1932 by 1932 pixels
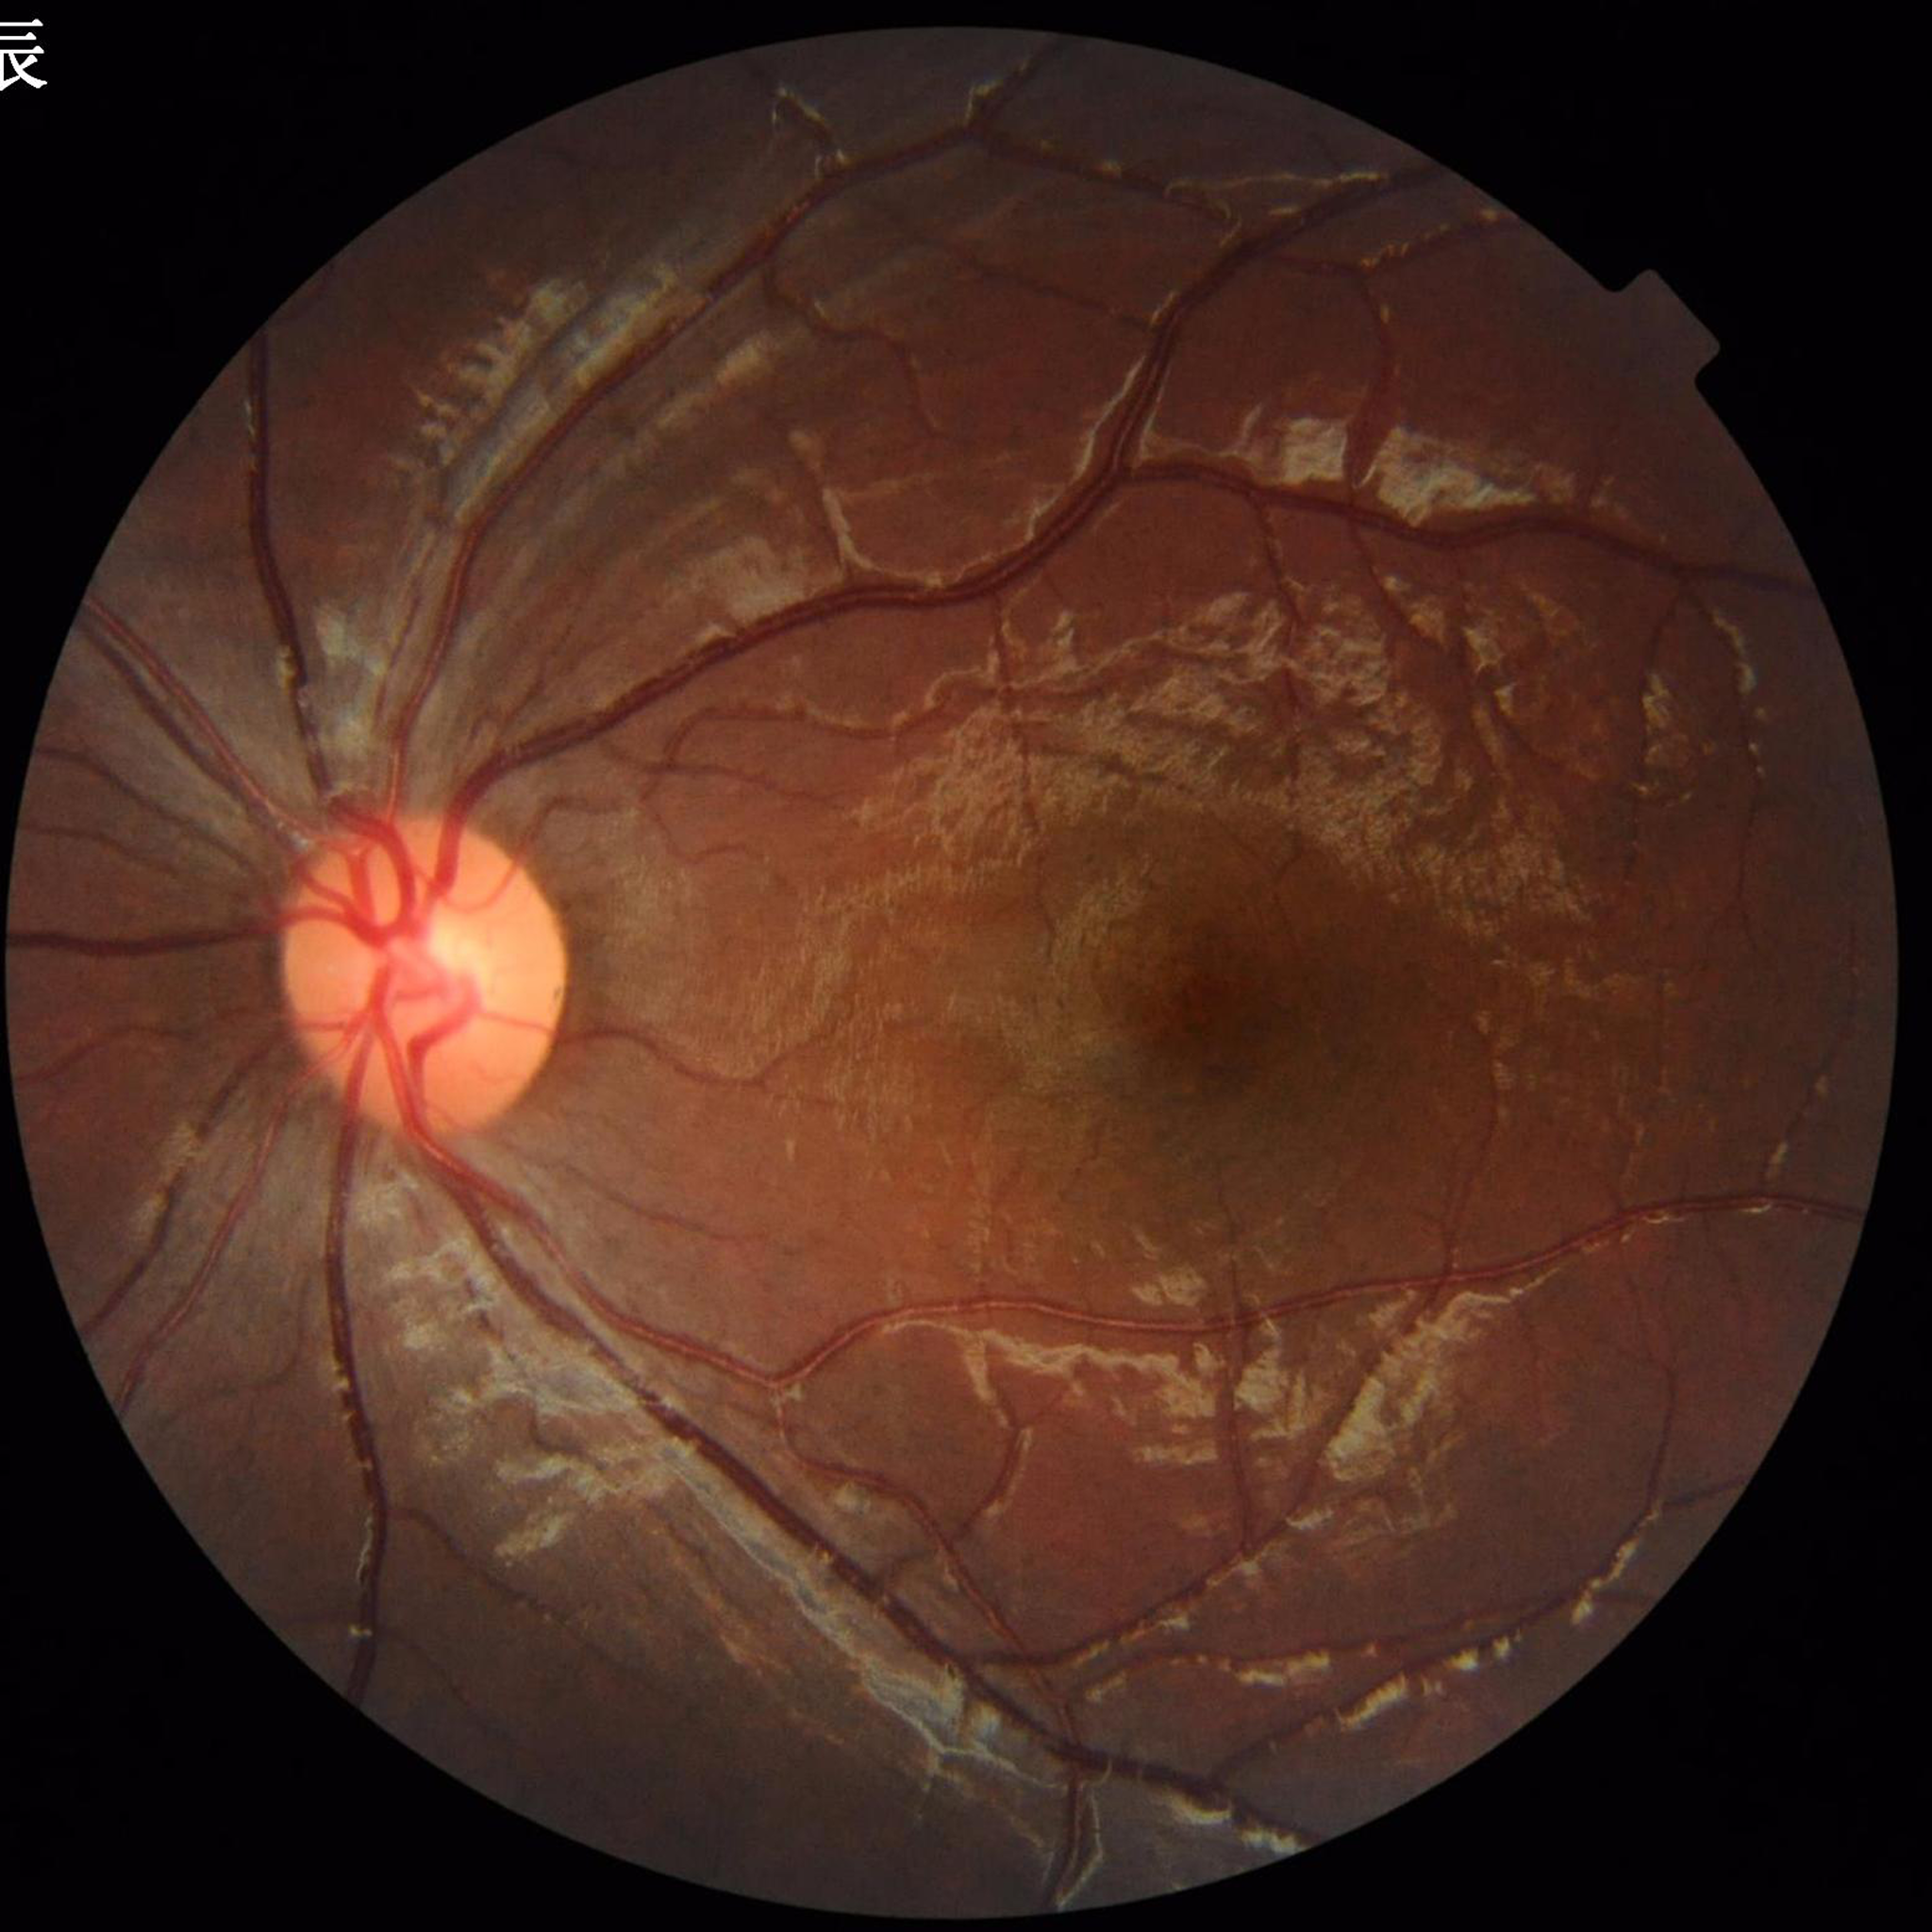

Image quality: good
Clinical diagnosis: no AMD, DR, or glaucomatous findings